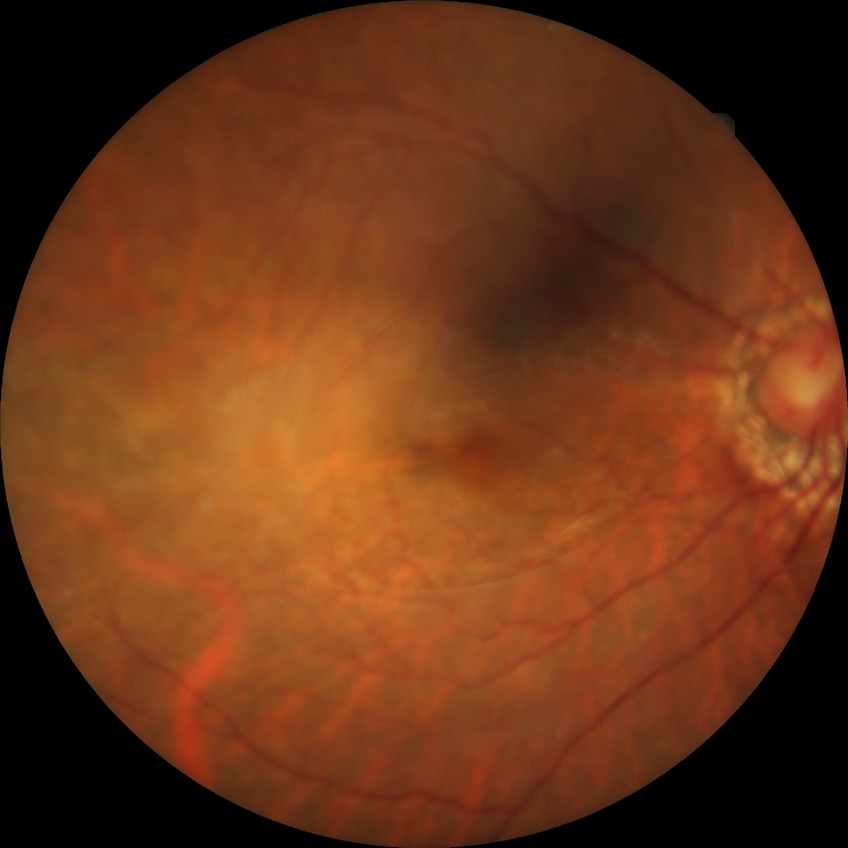

DR stage: NDR.
No apparent diabetic retinopathy.